1240 by 1240 pixels · wide-field fundus photograph of an infant.
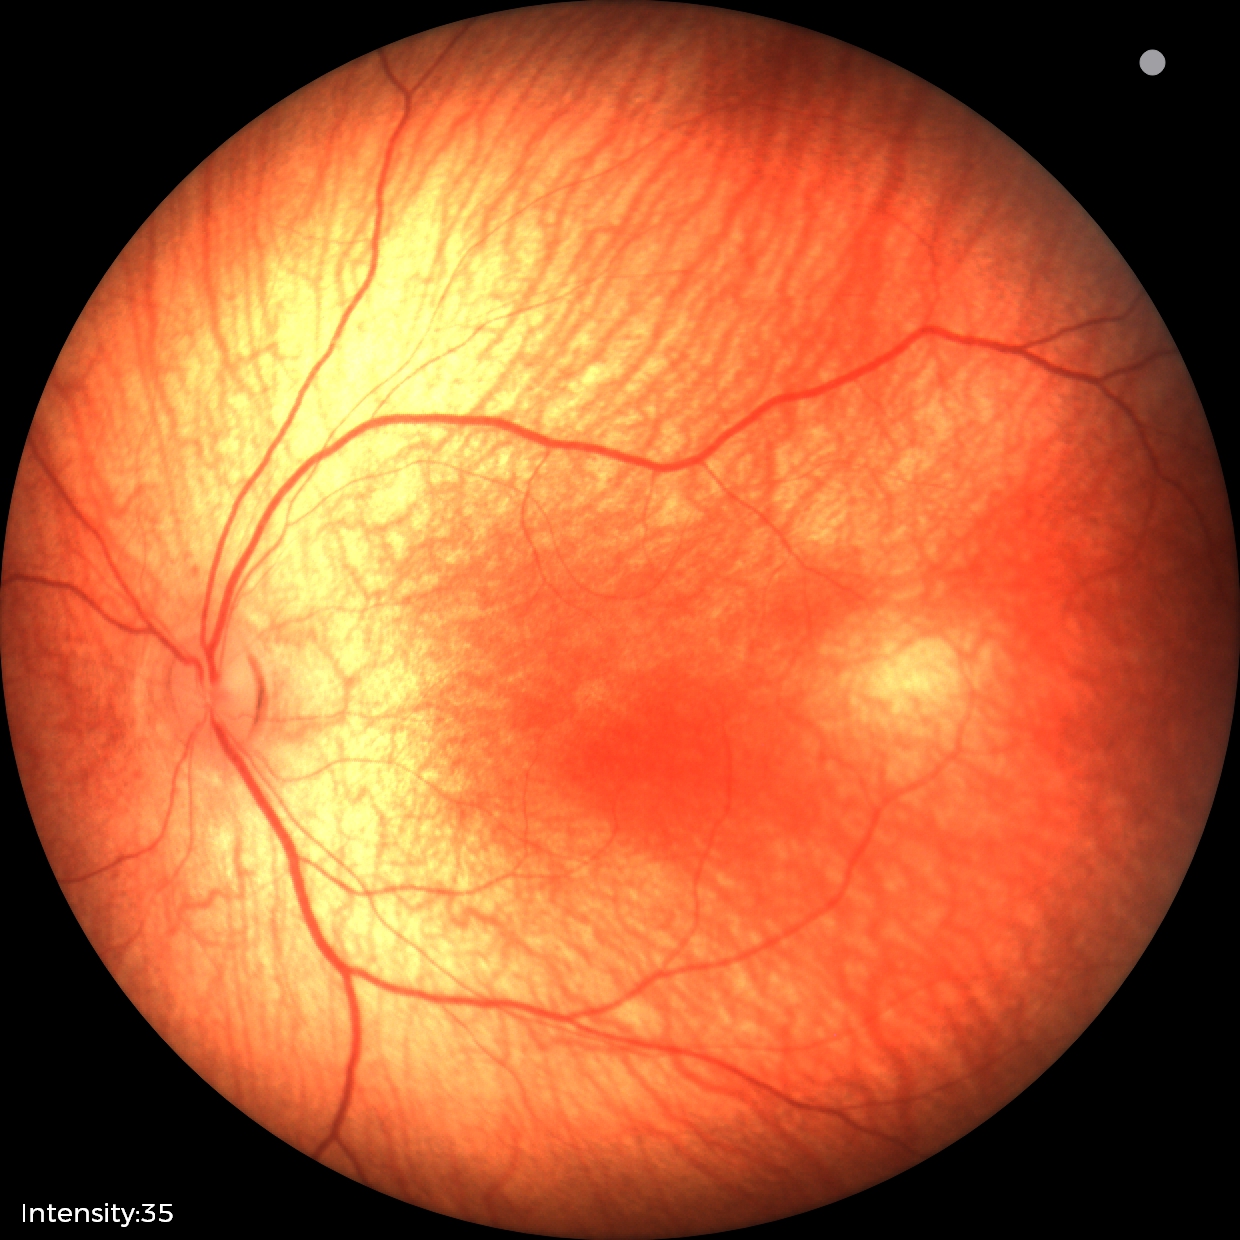

Screening diagnosis: physiological retinal finding.